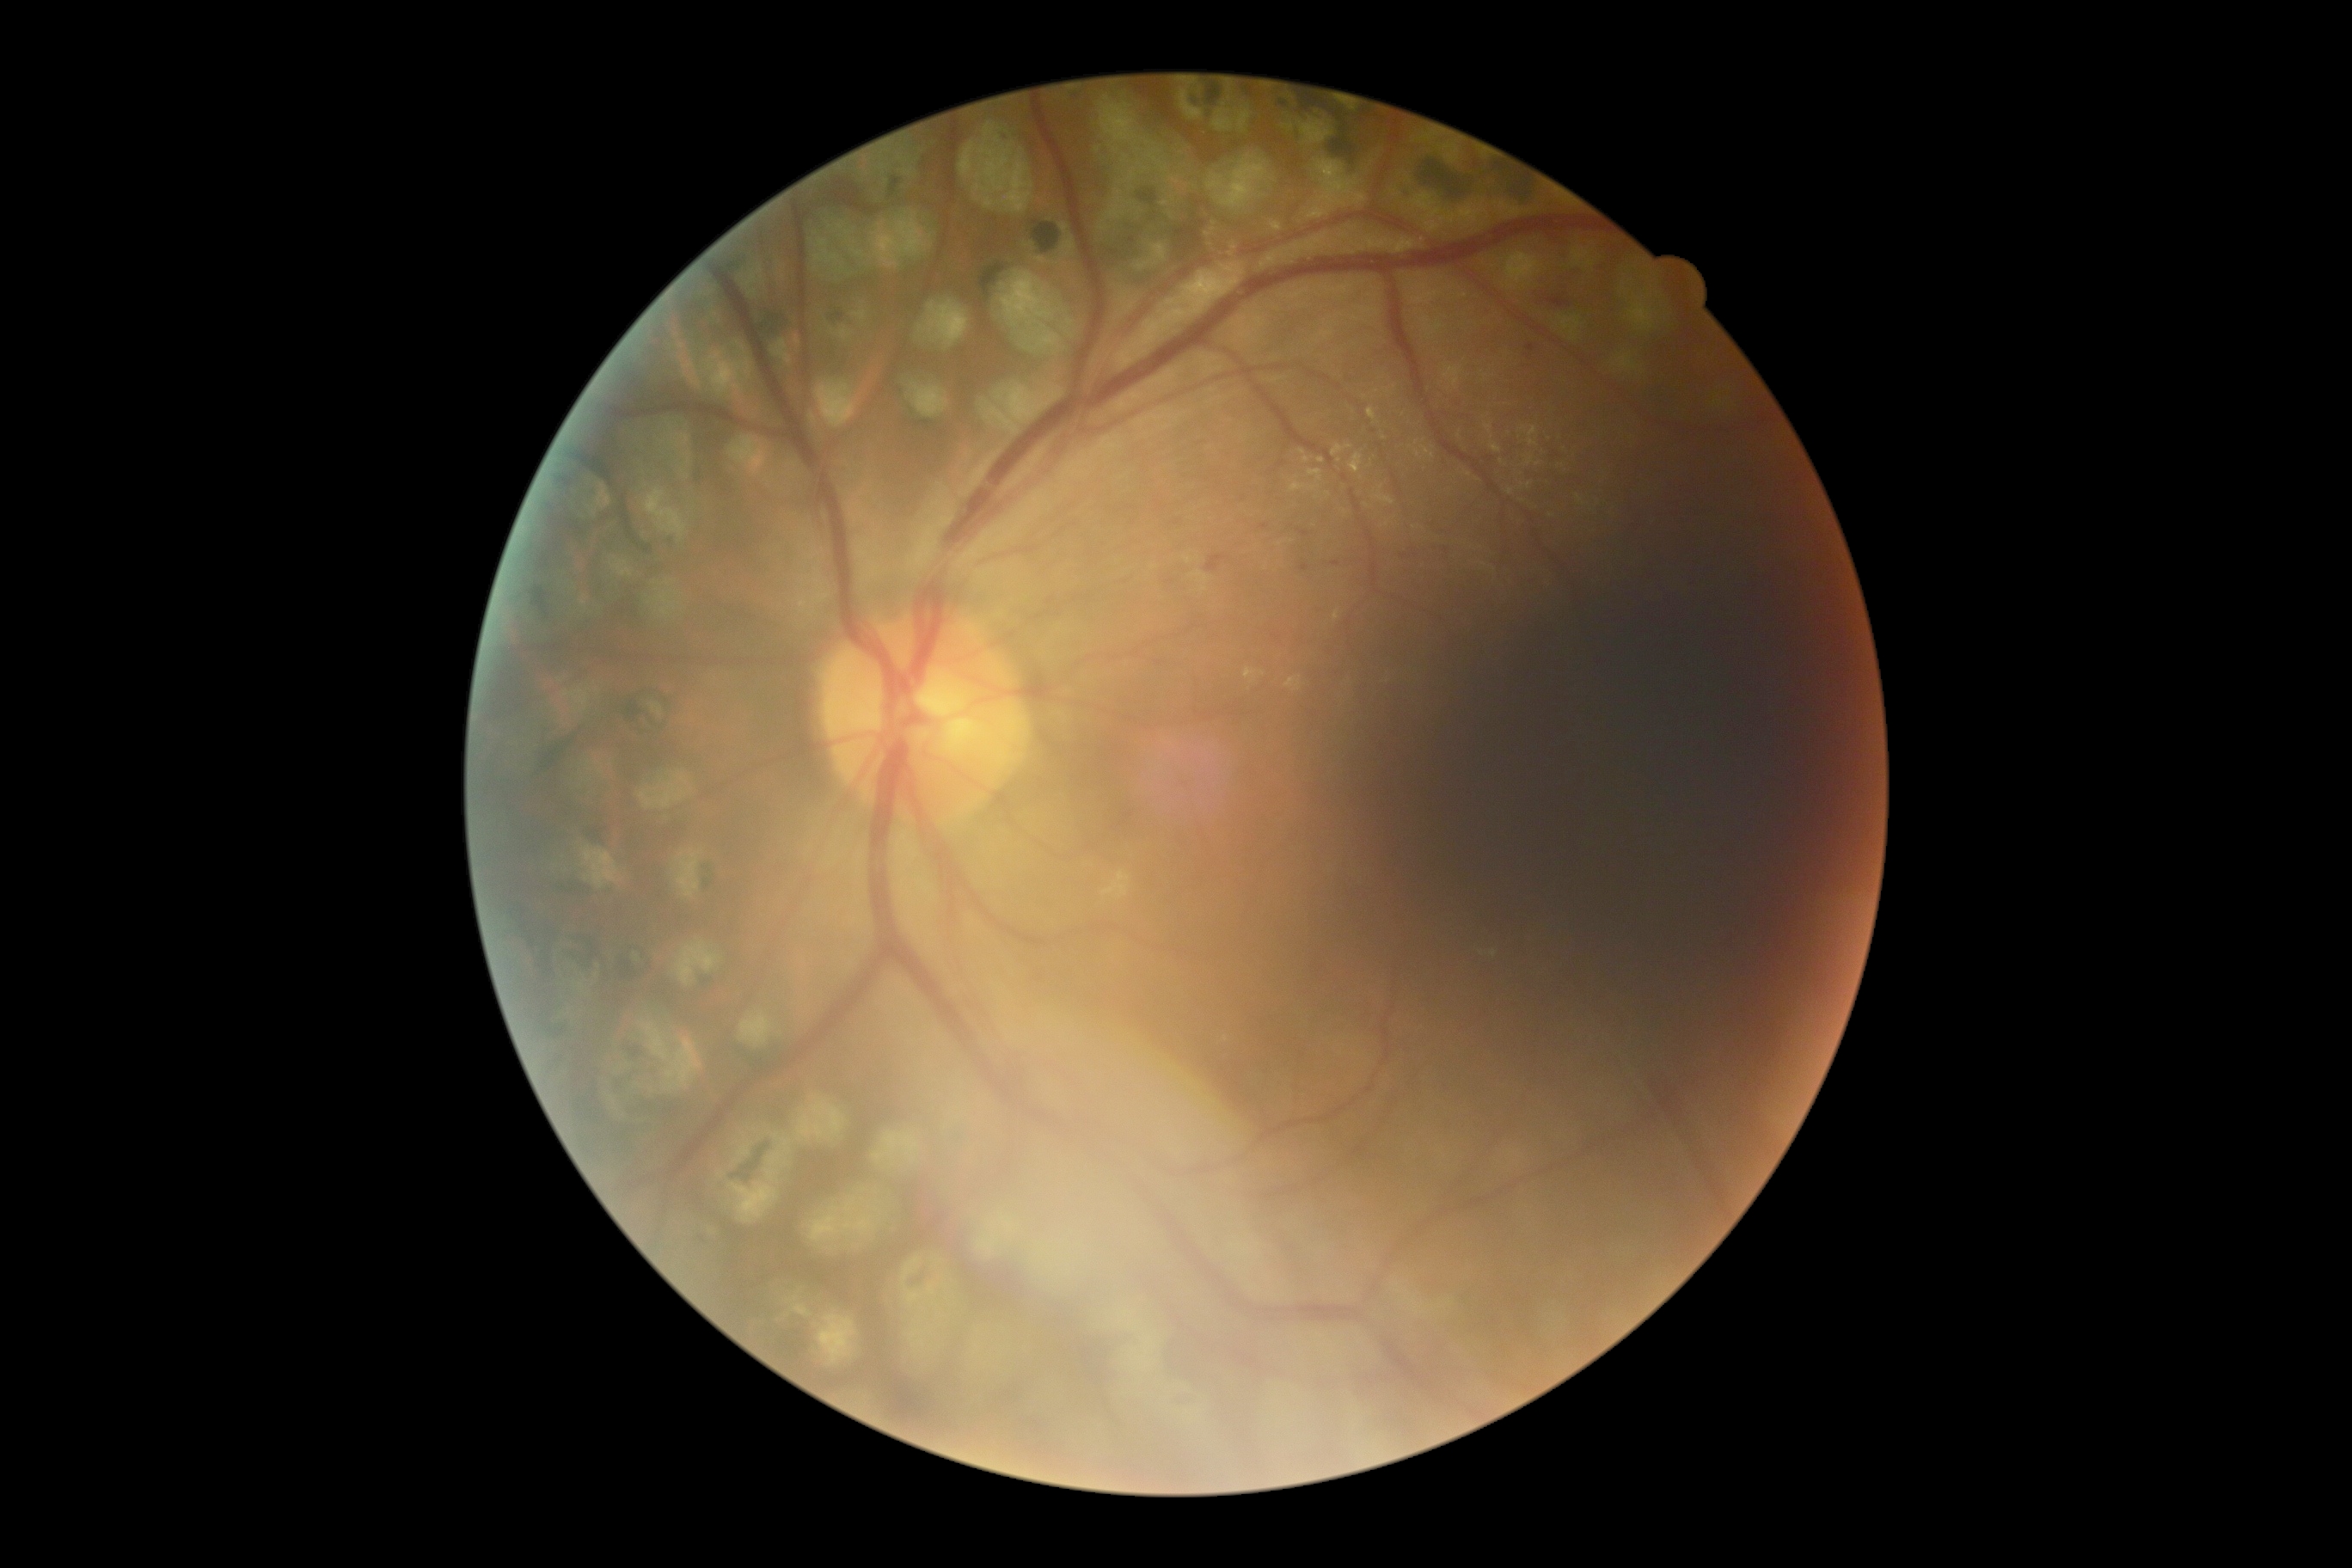

DR is moderate NPDR (grade 2).